Wide-field retinal mosaic image. 1924 x 1556 pixels.
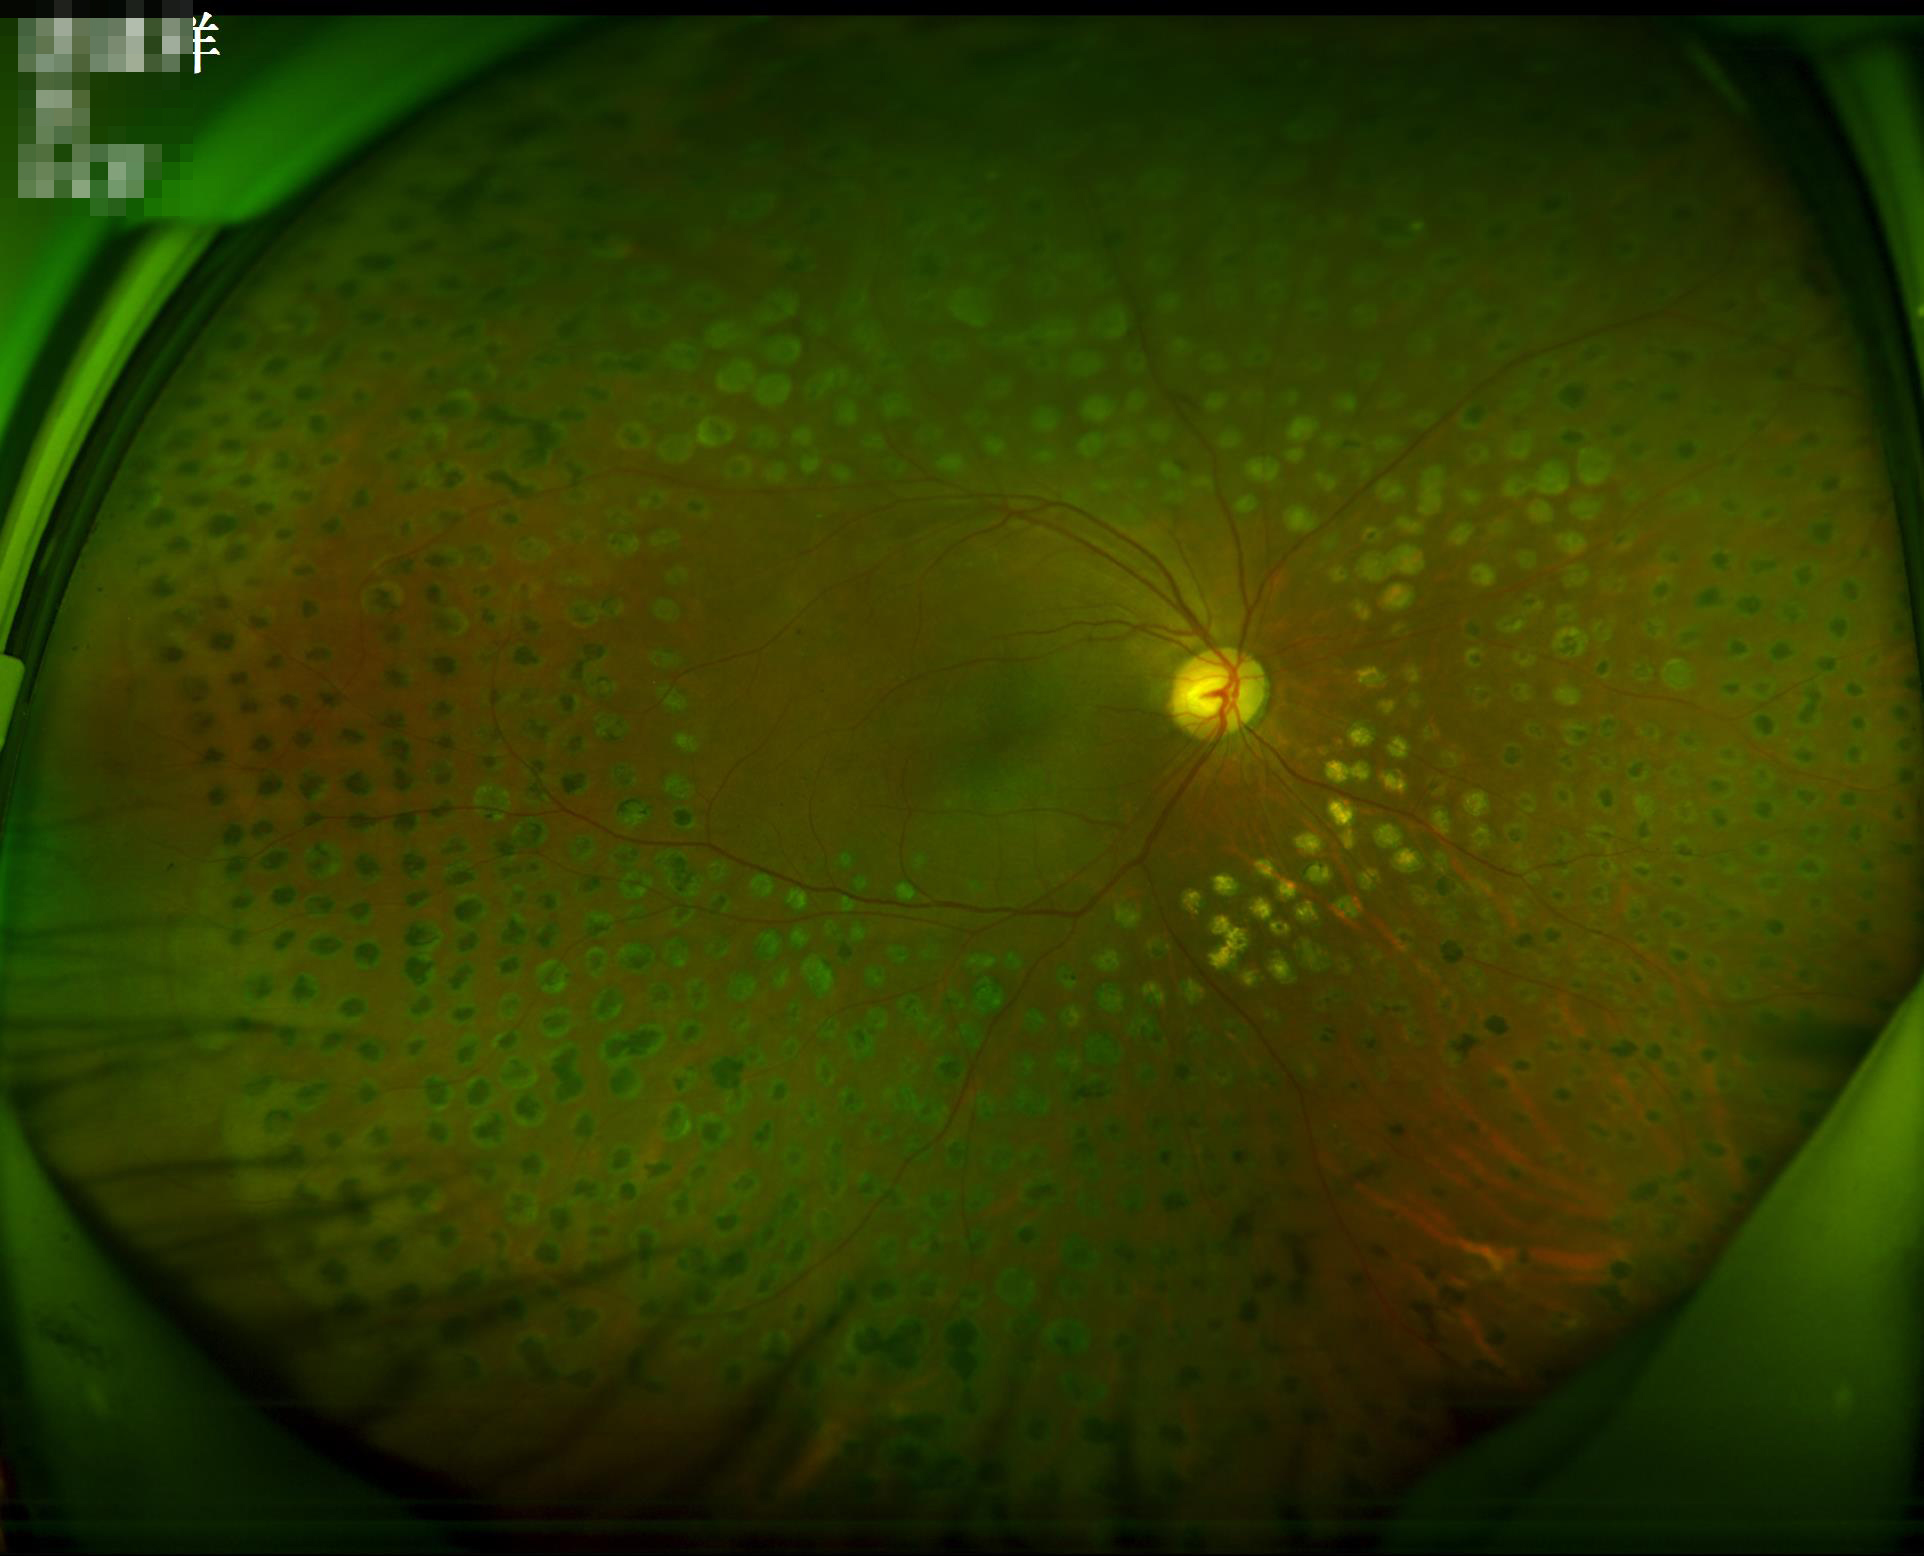

Optic disc, vessels, and background are in focus.
Acceptable image quality.
Illumination is even.
Adequate contrast for distinguishing structures.